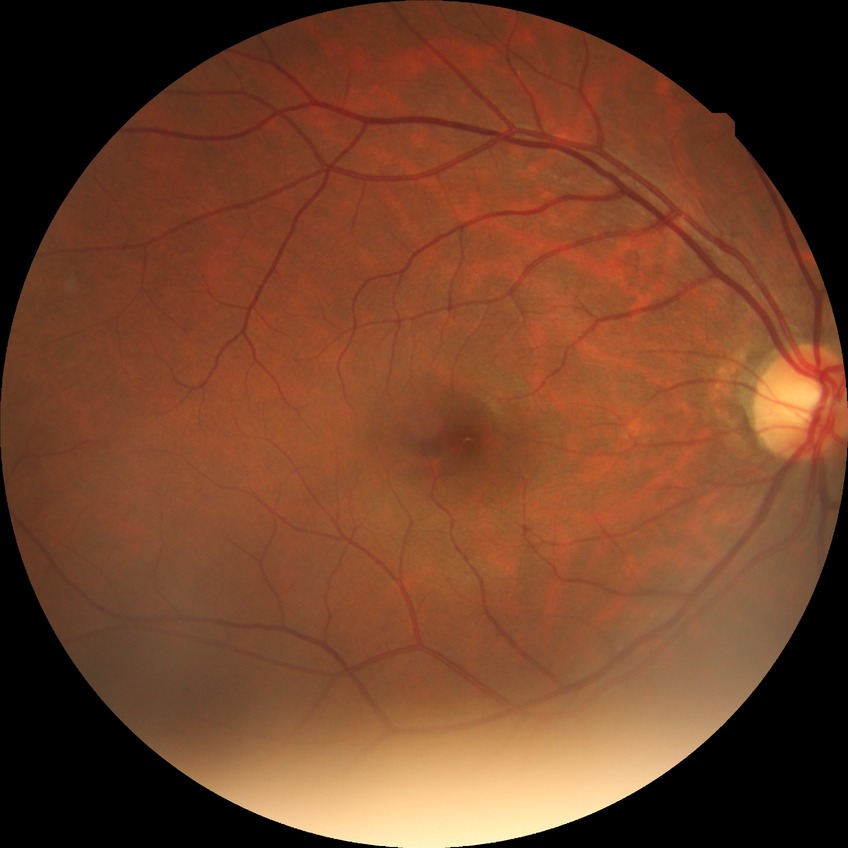

Diabetic retinopathy (DR): NDR (no diabetic retinopathy).